45-degree field of view, color fundus image, image size 1536x1152
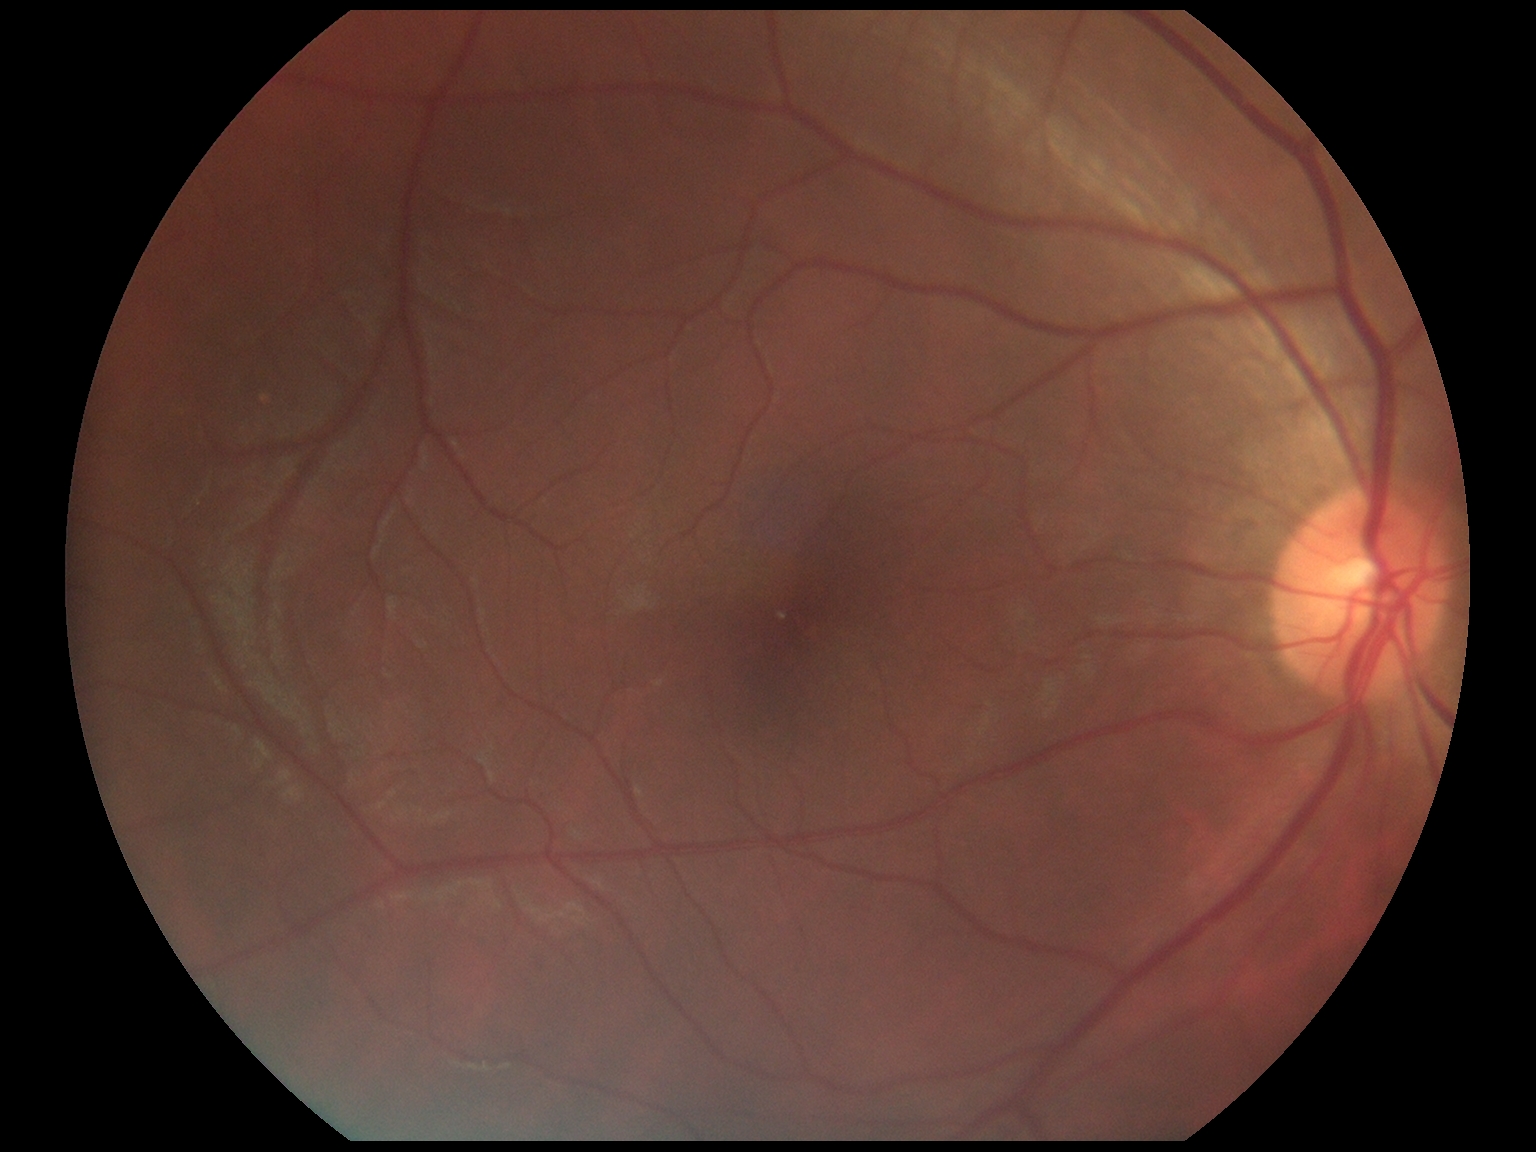

Diabetic retinopathy (DR): grade 0.